2352x1568:
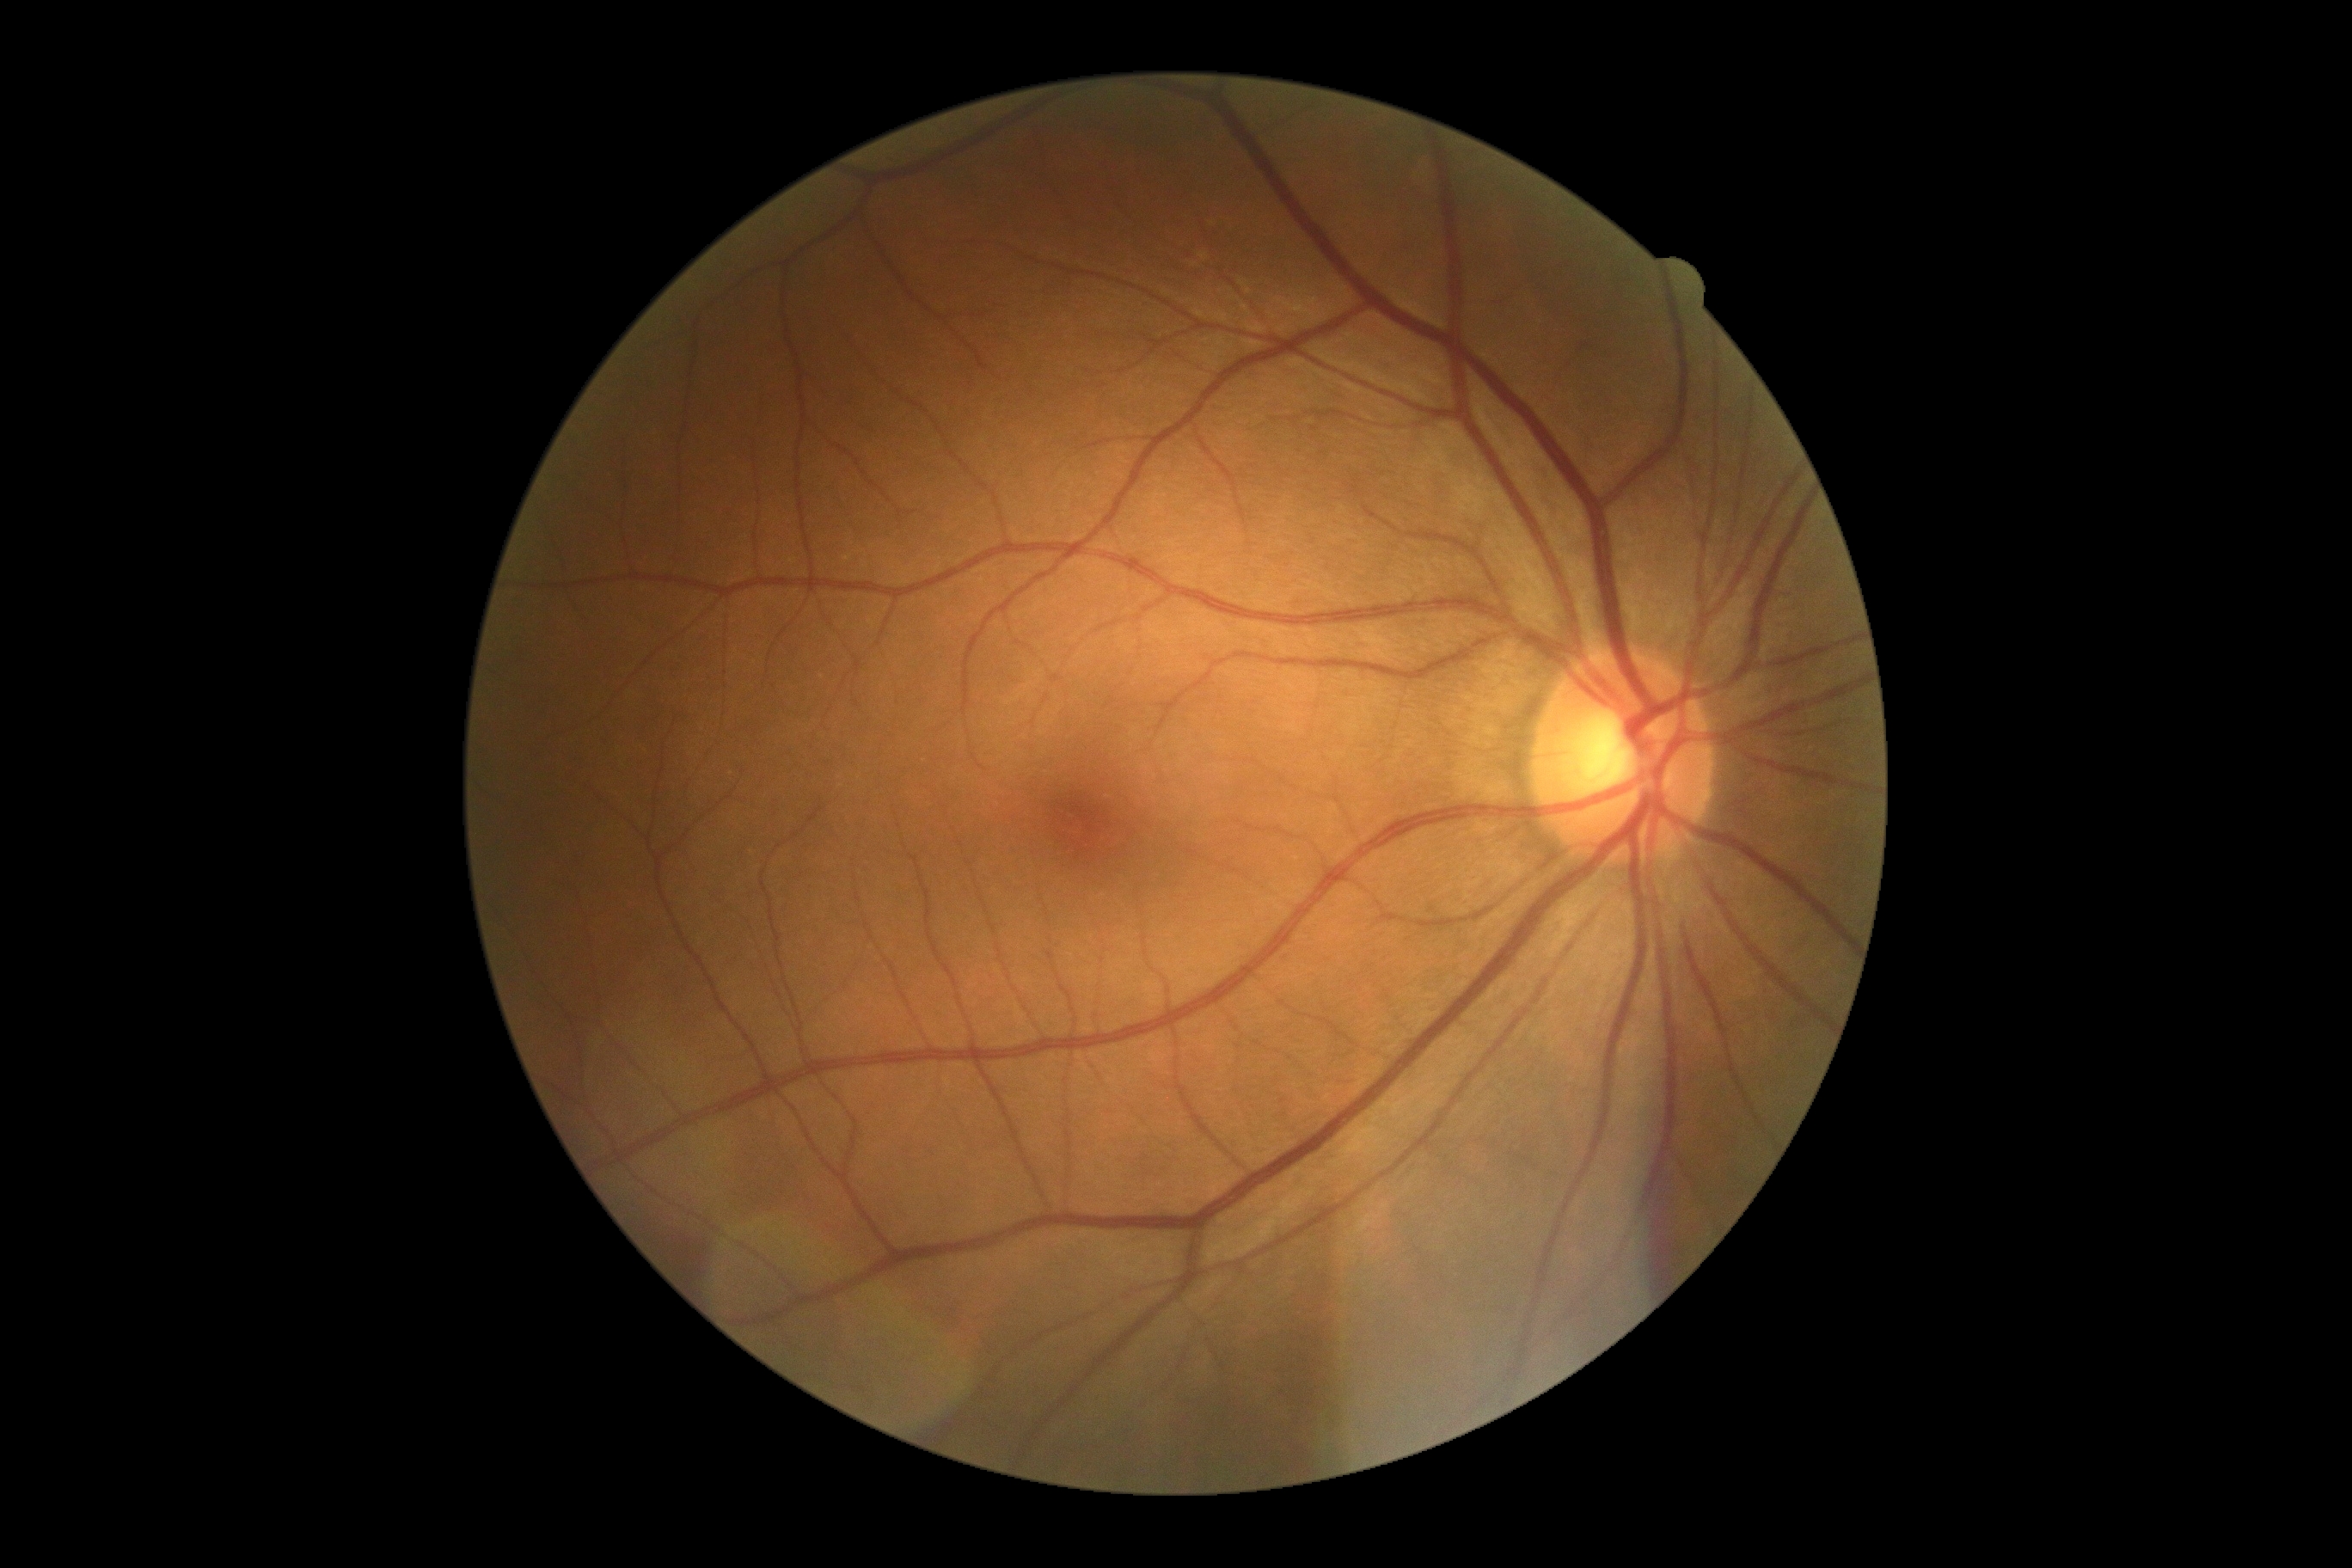
DR: grade 0 (no apparent retinopathy). No DR findings.